Graded on the modified Davis scale — 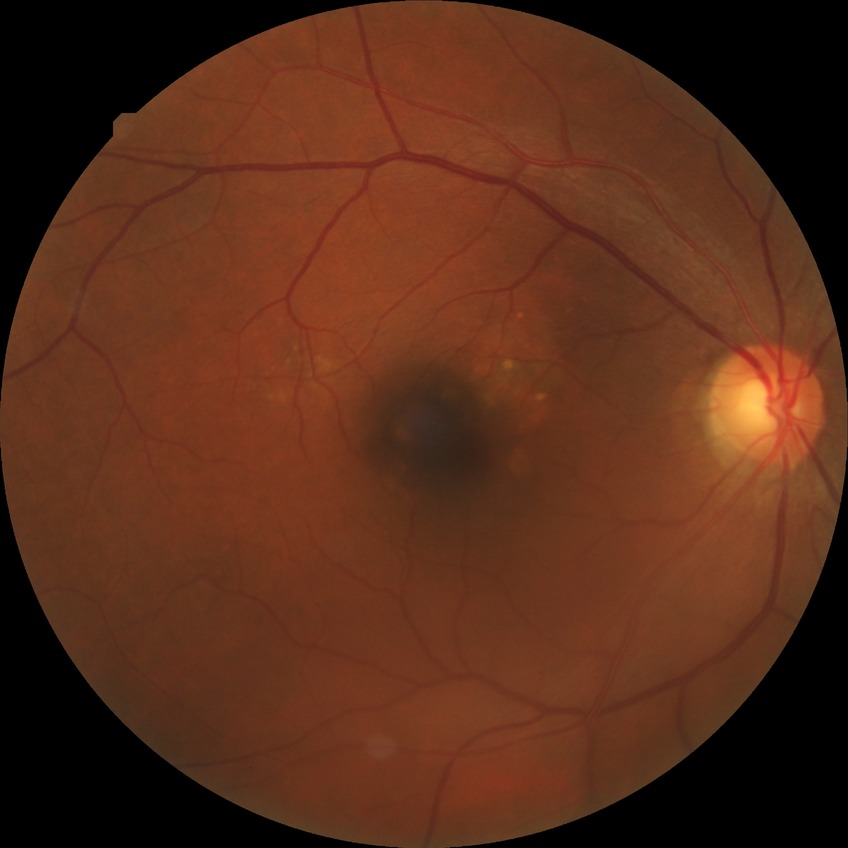
Diabetic retinopathy severity is no diabetic retinopathy.